Color fundus photograph · 45-degree field of view:
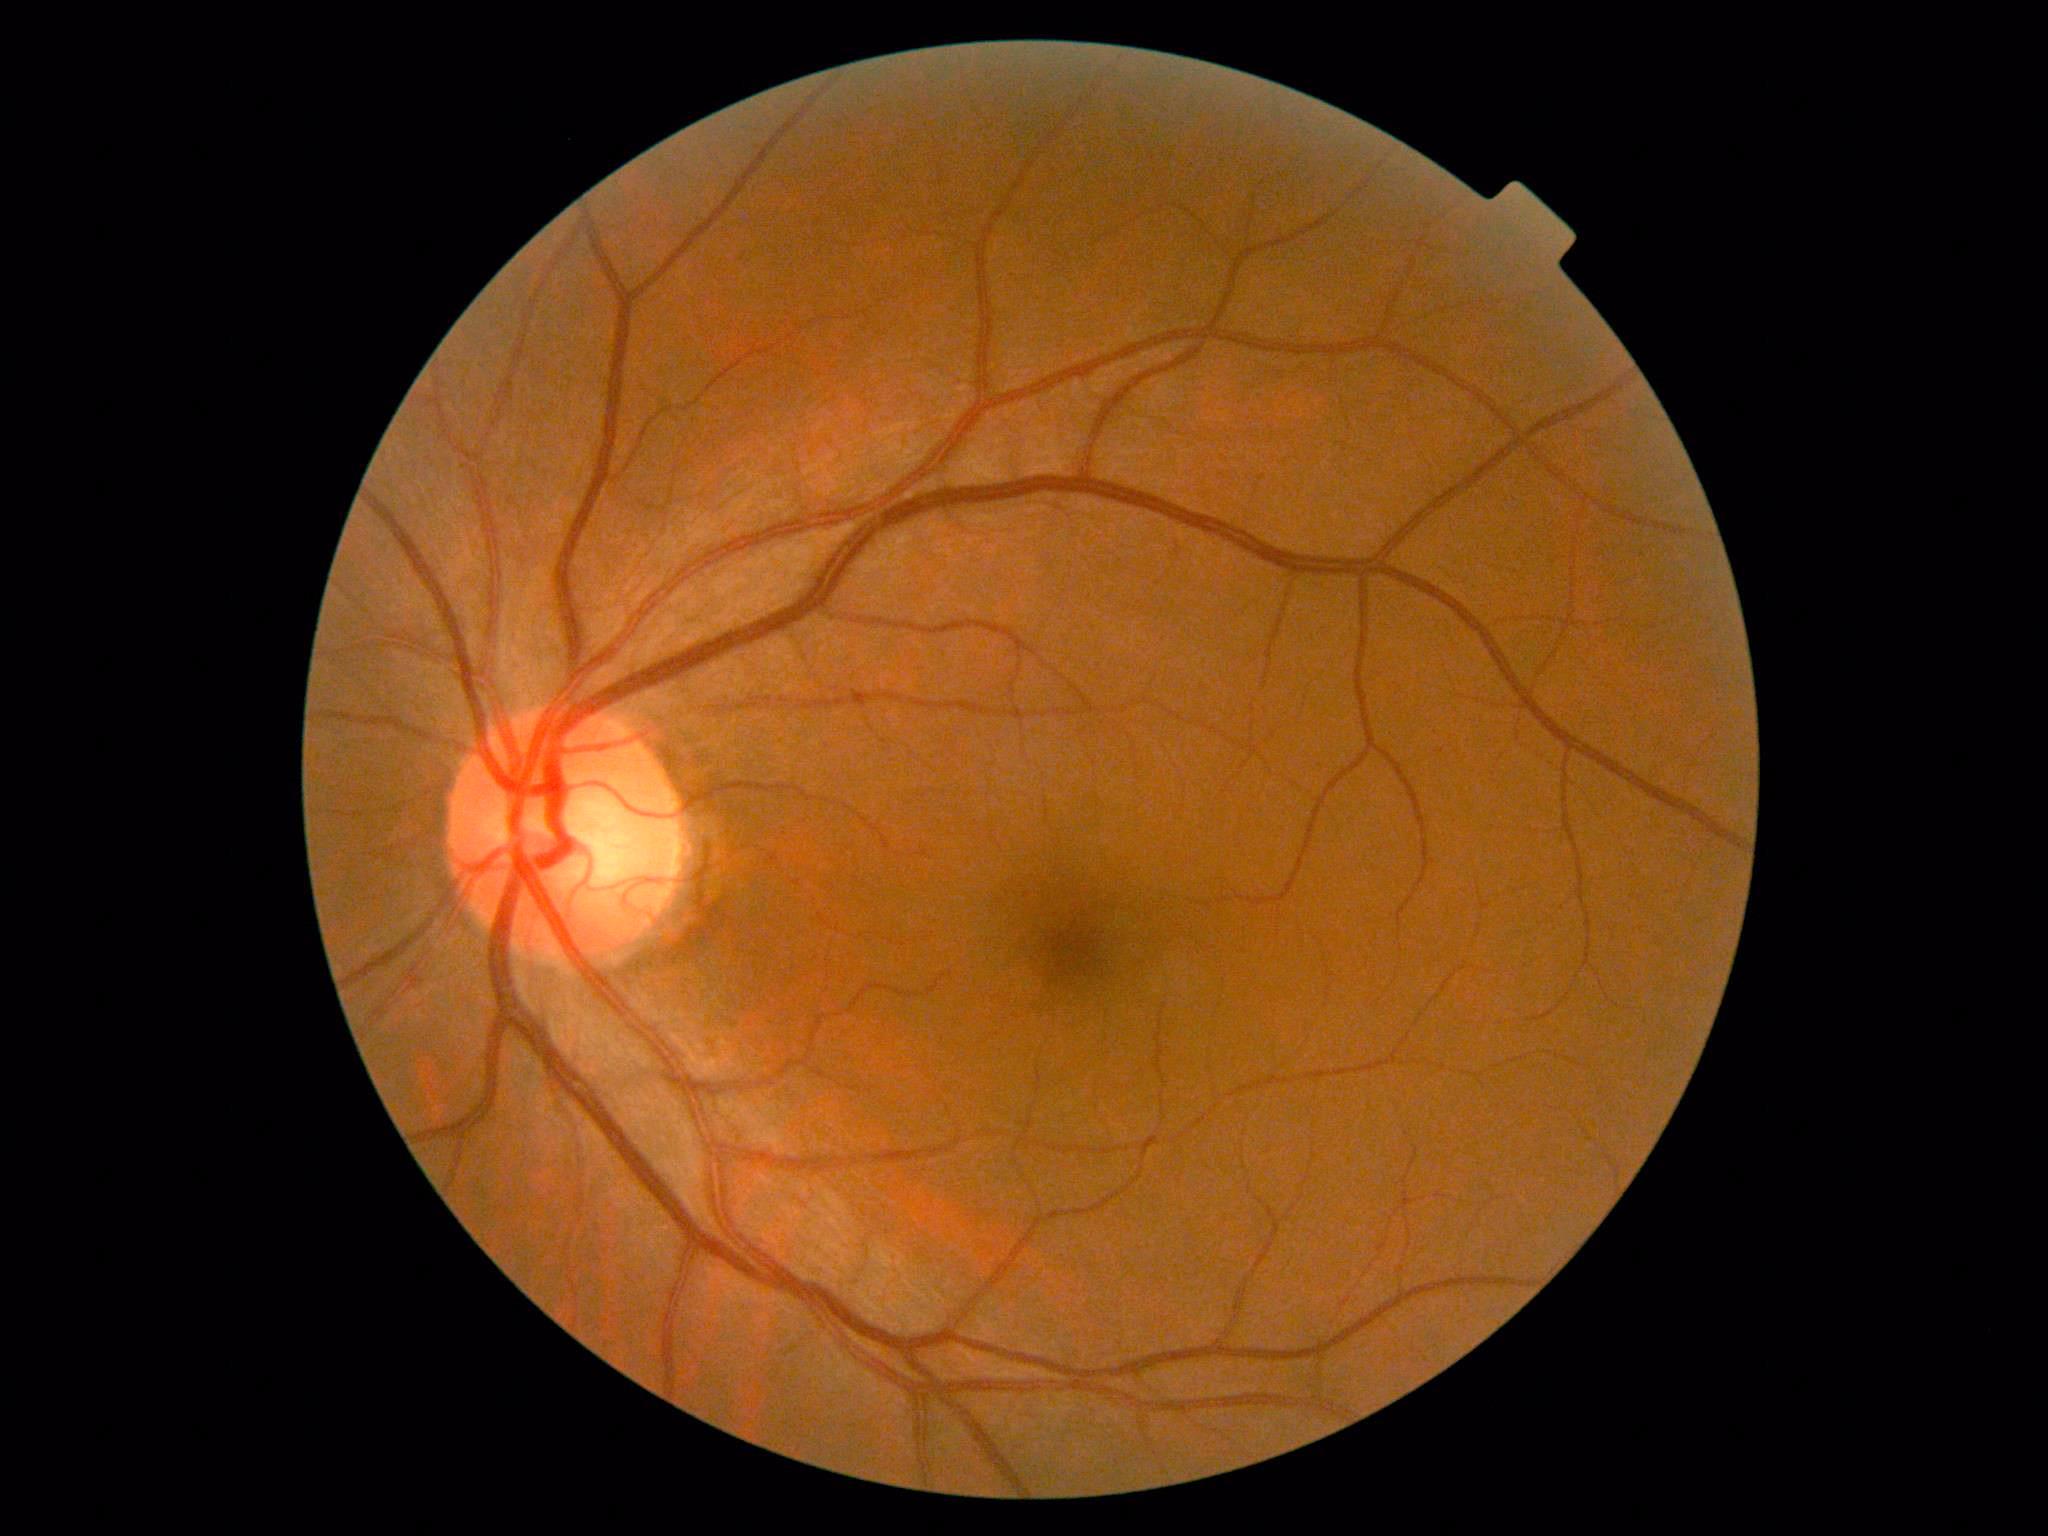
* retinopathy: 0